Camera: Natus RetCam Envision (130° FOV) · wide-field fundus photograph of an infant · 1440x1080px:
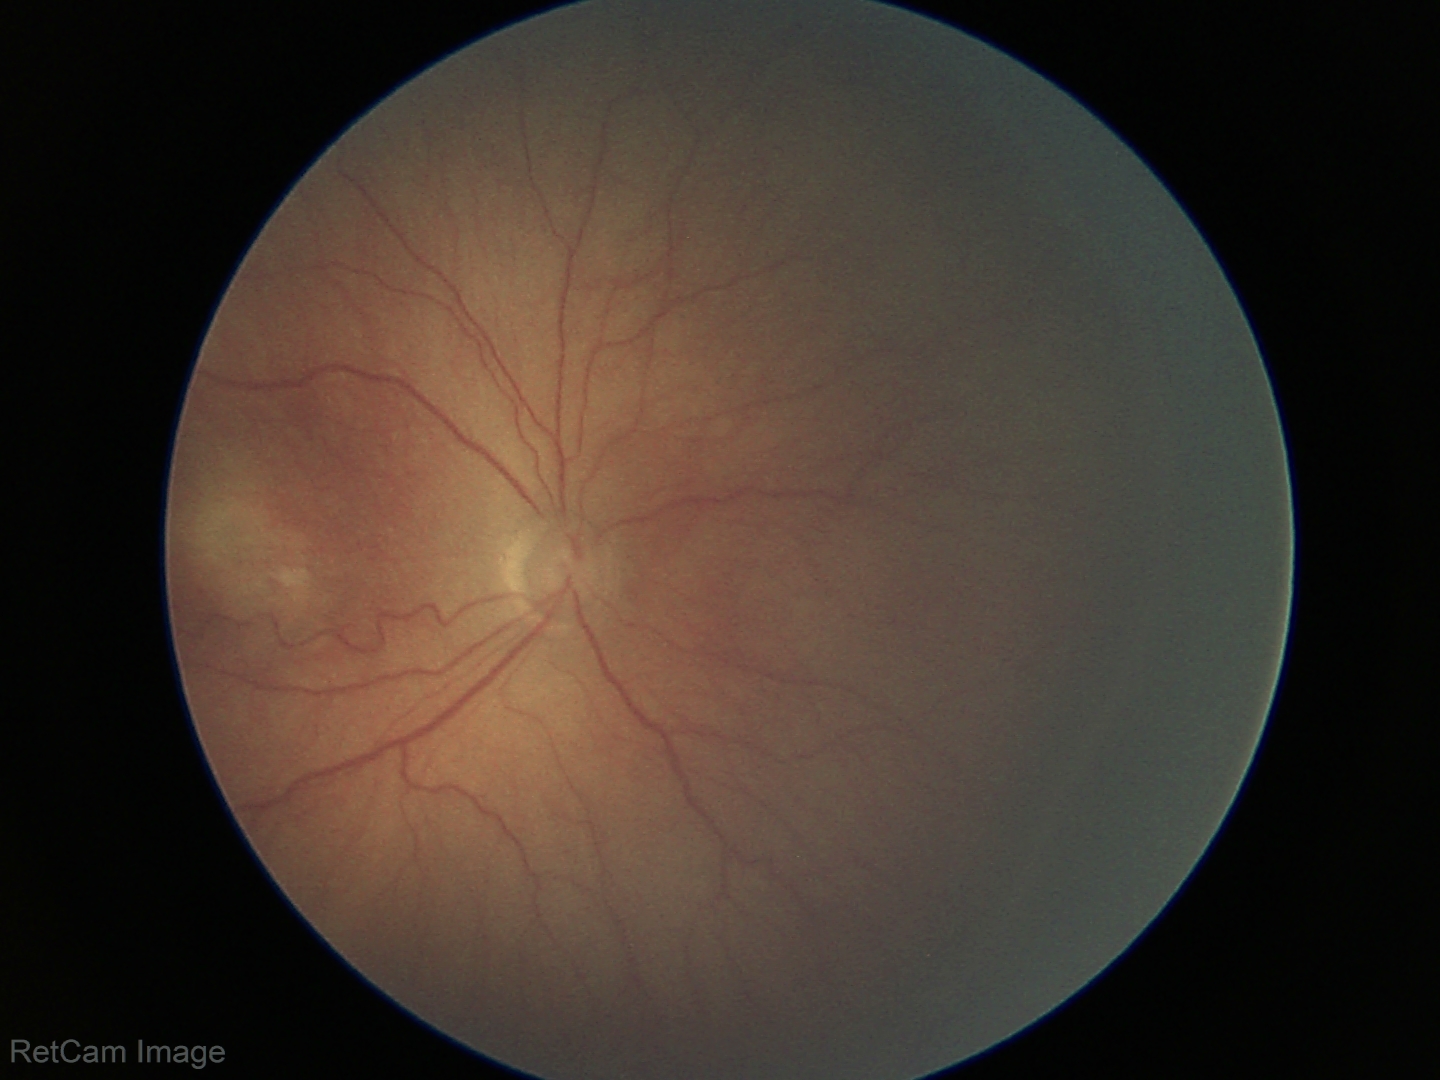 Diagnosis from this screening exam: retinopathy of prematurity stage 3 — ridge with extraretinal fibrovascular proliferation. Plus disease absent.